Natus RetCam Envision, 130° FOV; wide-field fundus image from infant ROP screening:
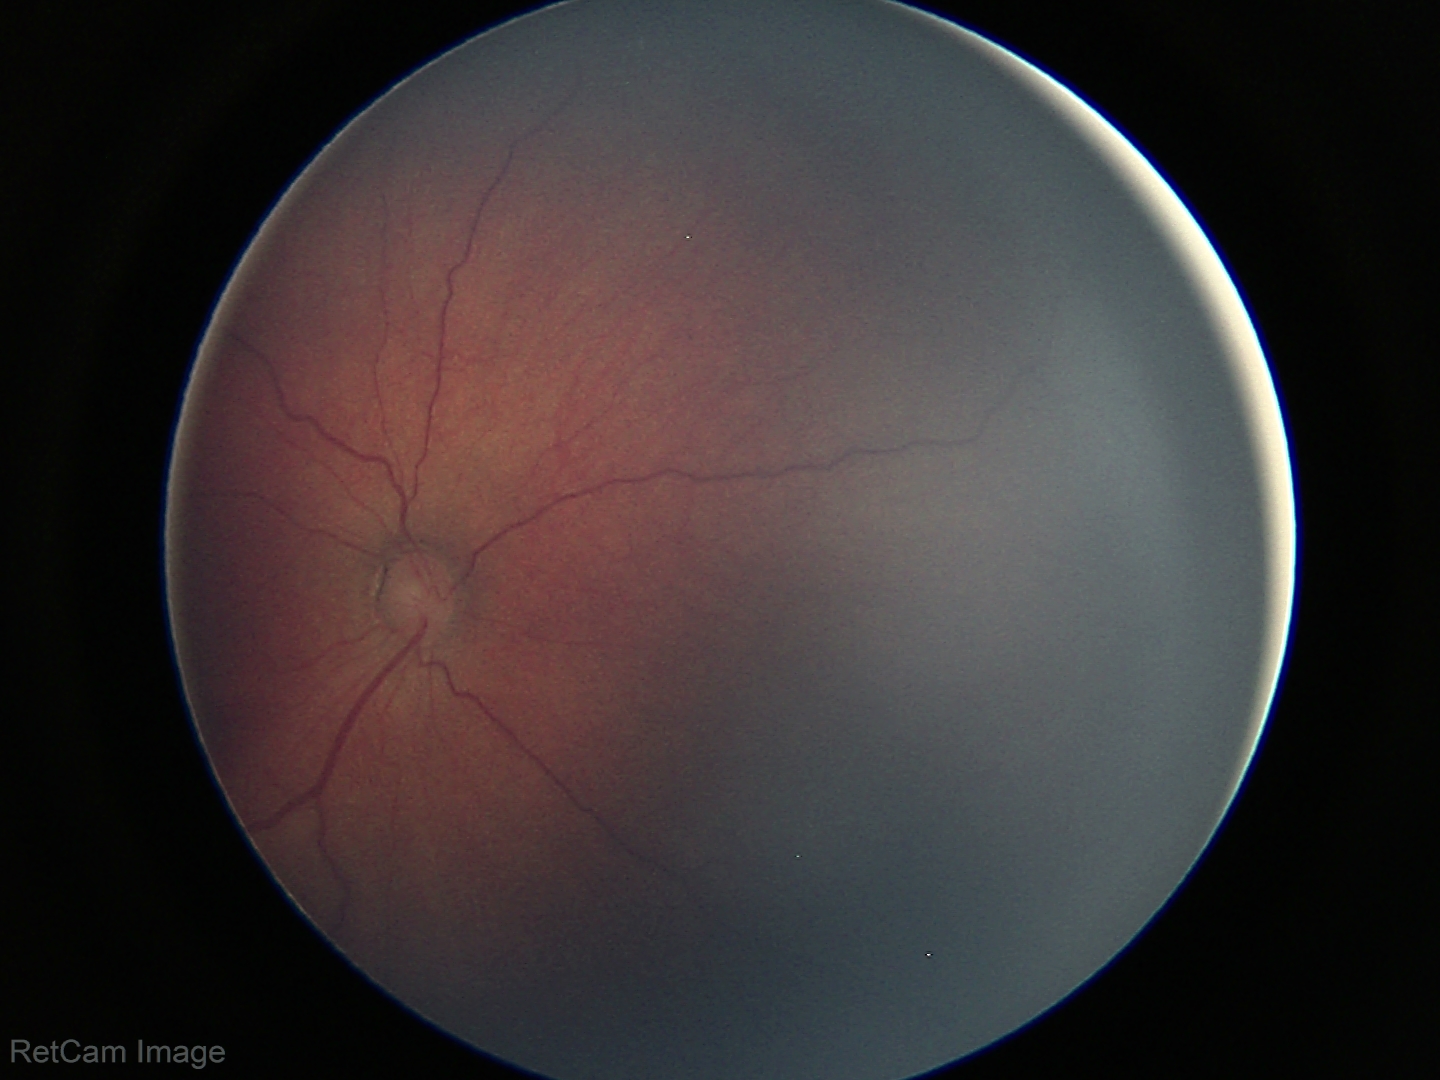
Examination diagnosed as retinopathy of prematurity stage 3. No plus disease.